Camera: Clarity RetCam 3 (130° FOV). 640x480. Pediatric wide-field fundus photograph: 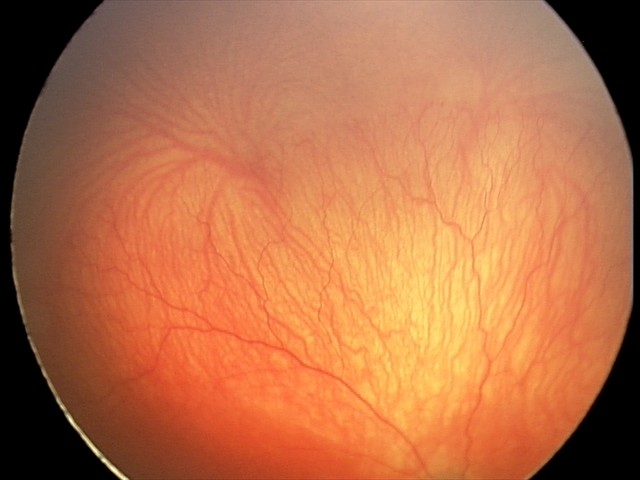
Finding: aggressive retinopathy of prematurity; plus disease: present.